848 by 848 pixels, 45-degree field of view: 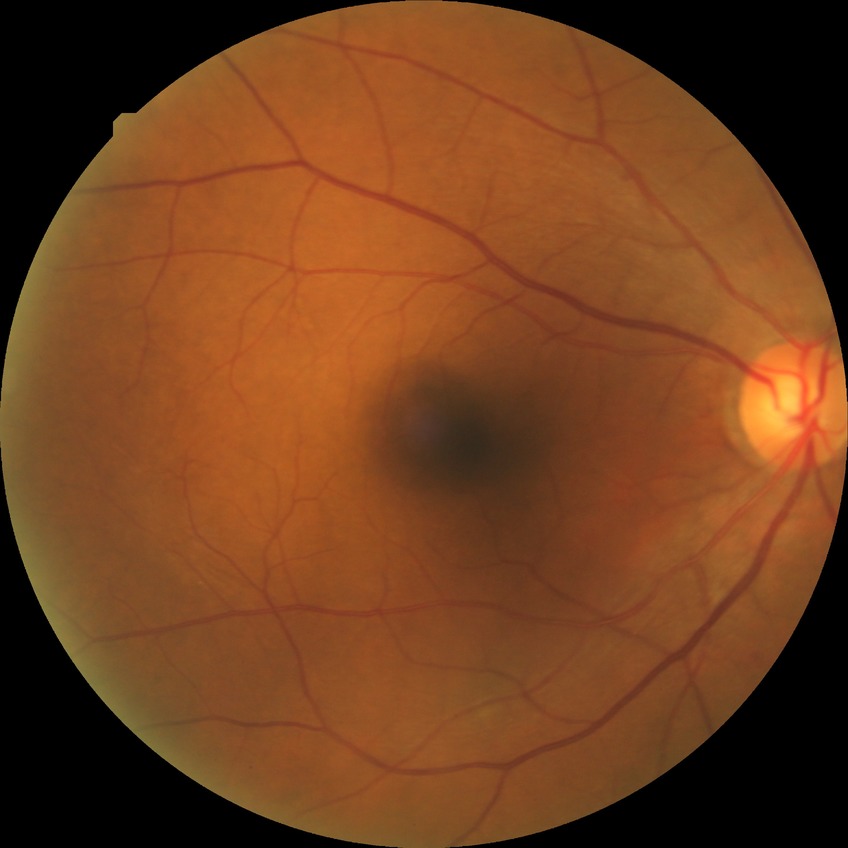 Diabetic retinopathy (DR) is no diabetic retinopathy (NDR).